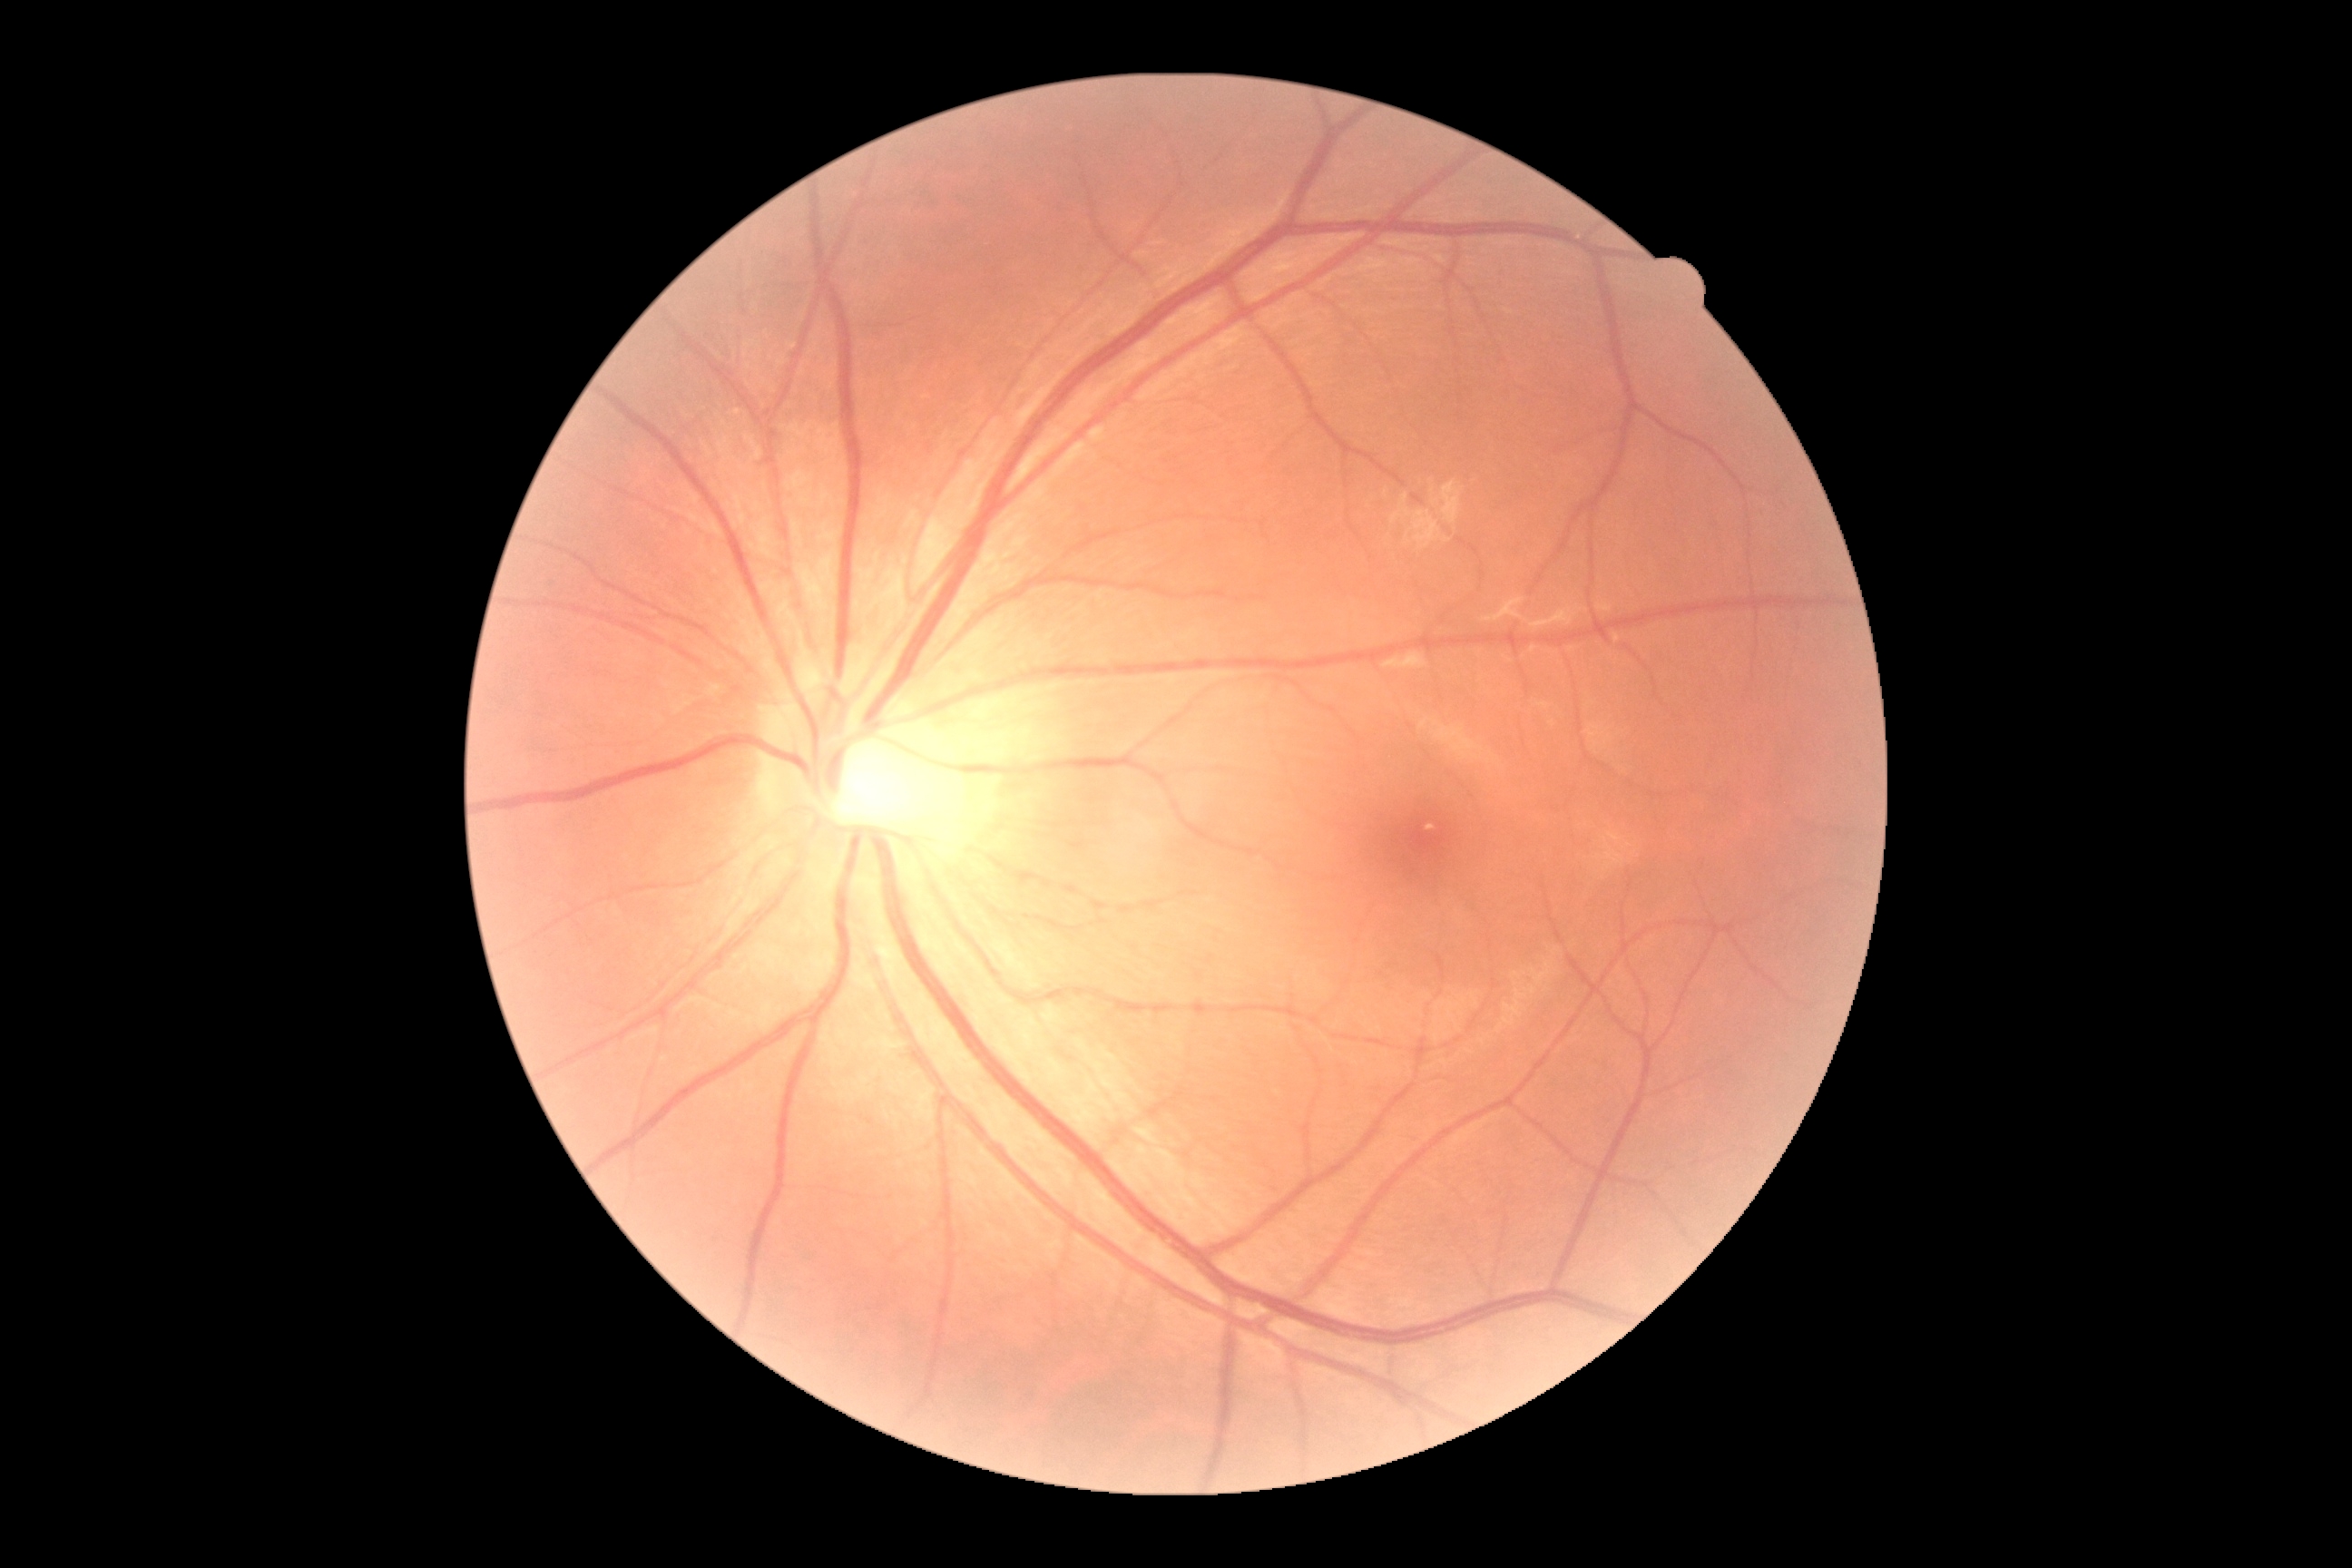
No diabetic retinal disease findings. Retinopathy is grade 0 (no apparent retinopathy).